640 x 480 pixels; infant wide-field fundus photograph: 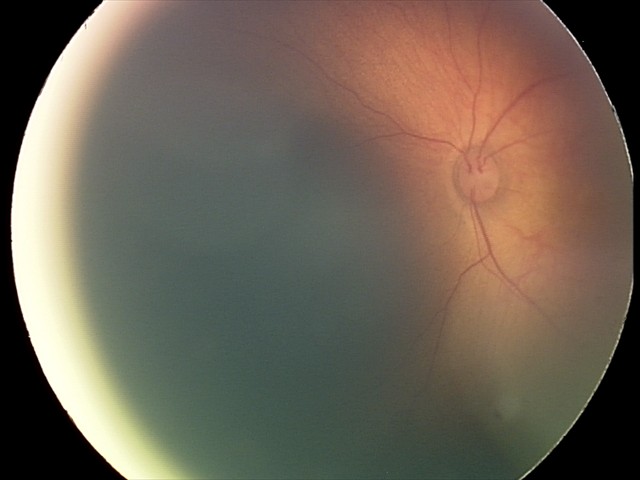

From an examination with diagnosis of retinal hemorrhages.